Pediatric retinal photograph (wide-field)
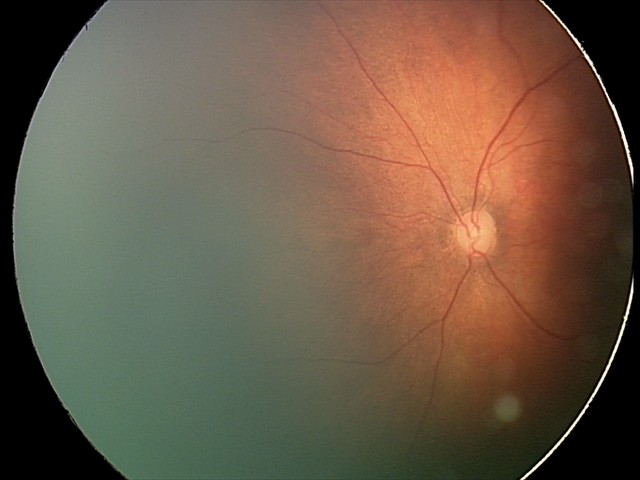 Screening examination diagnosed as physiological.